2228 x 1652 pixels; pupil-dilated; central posterior field
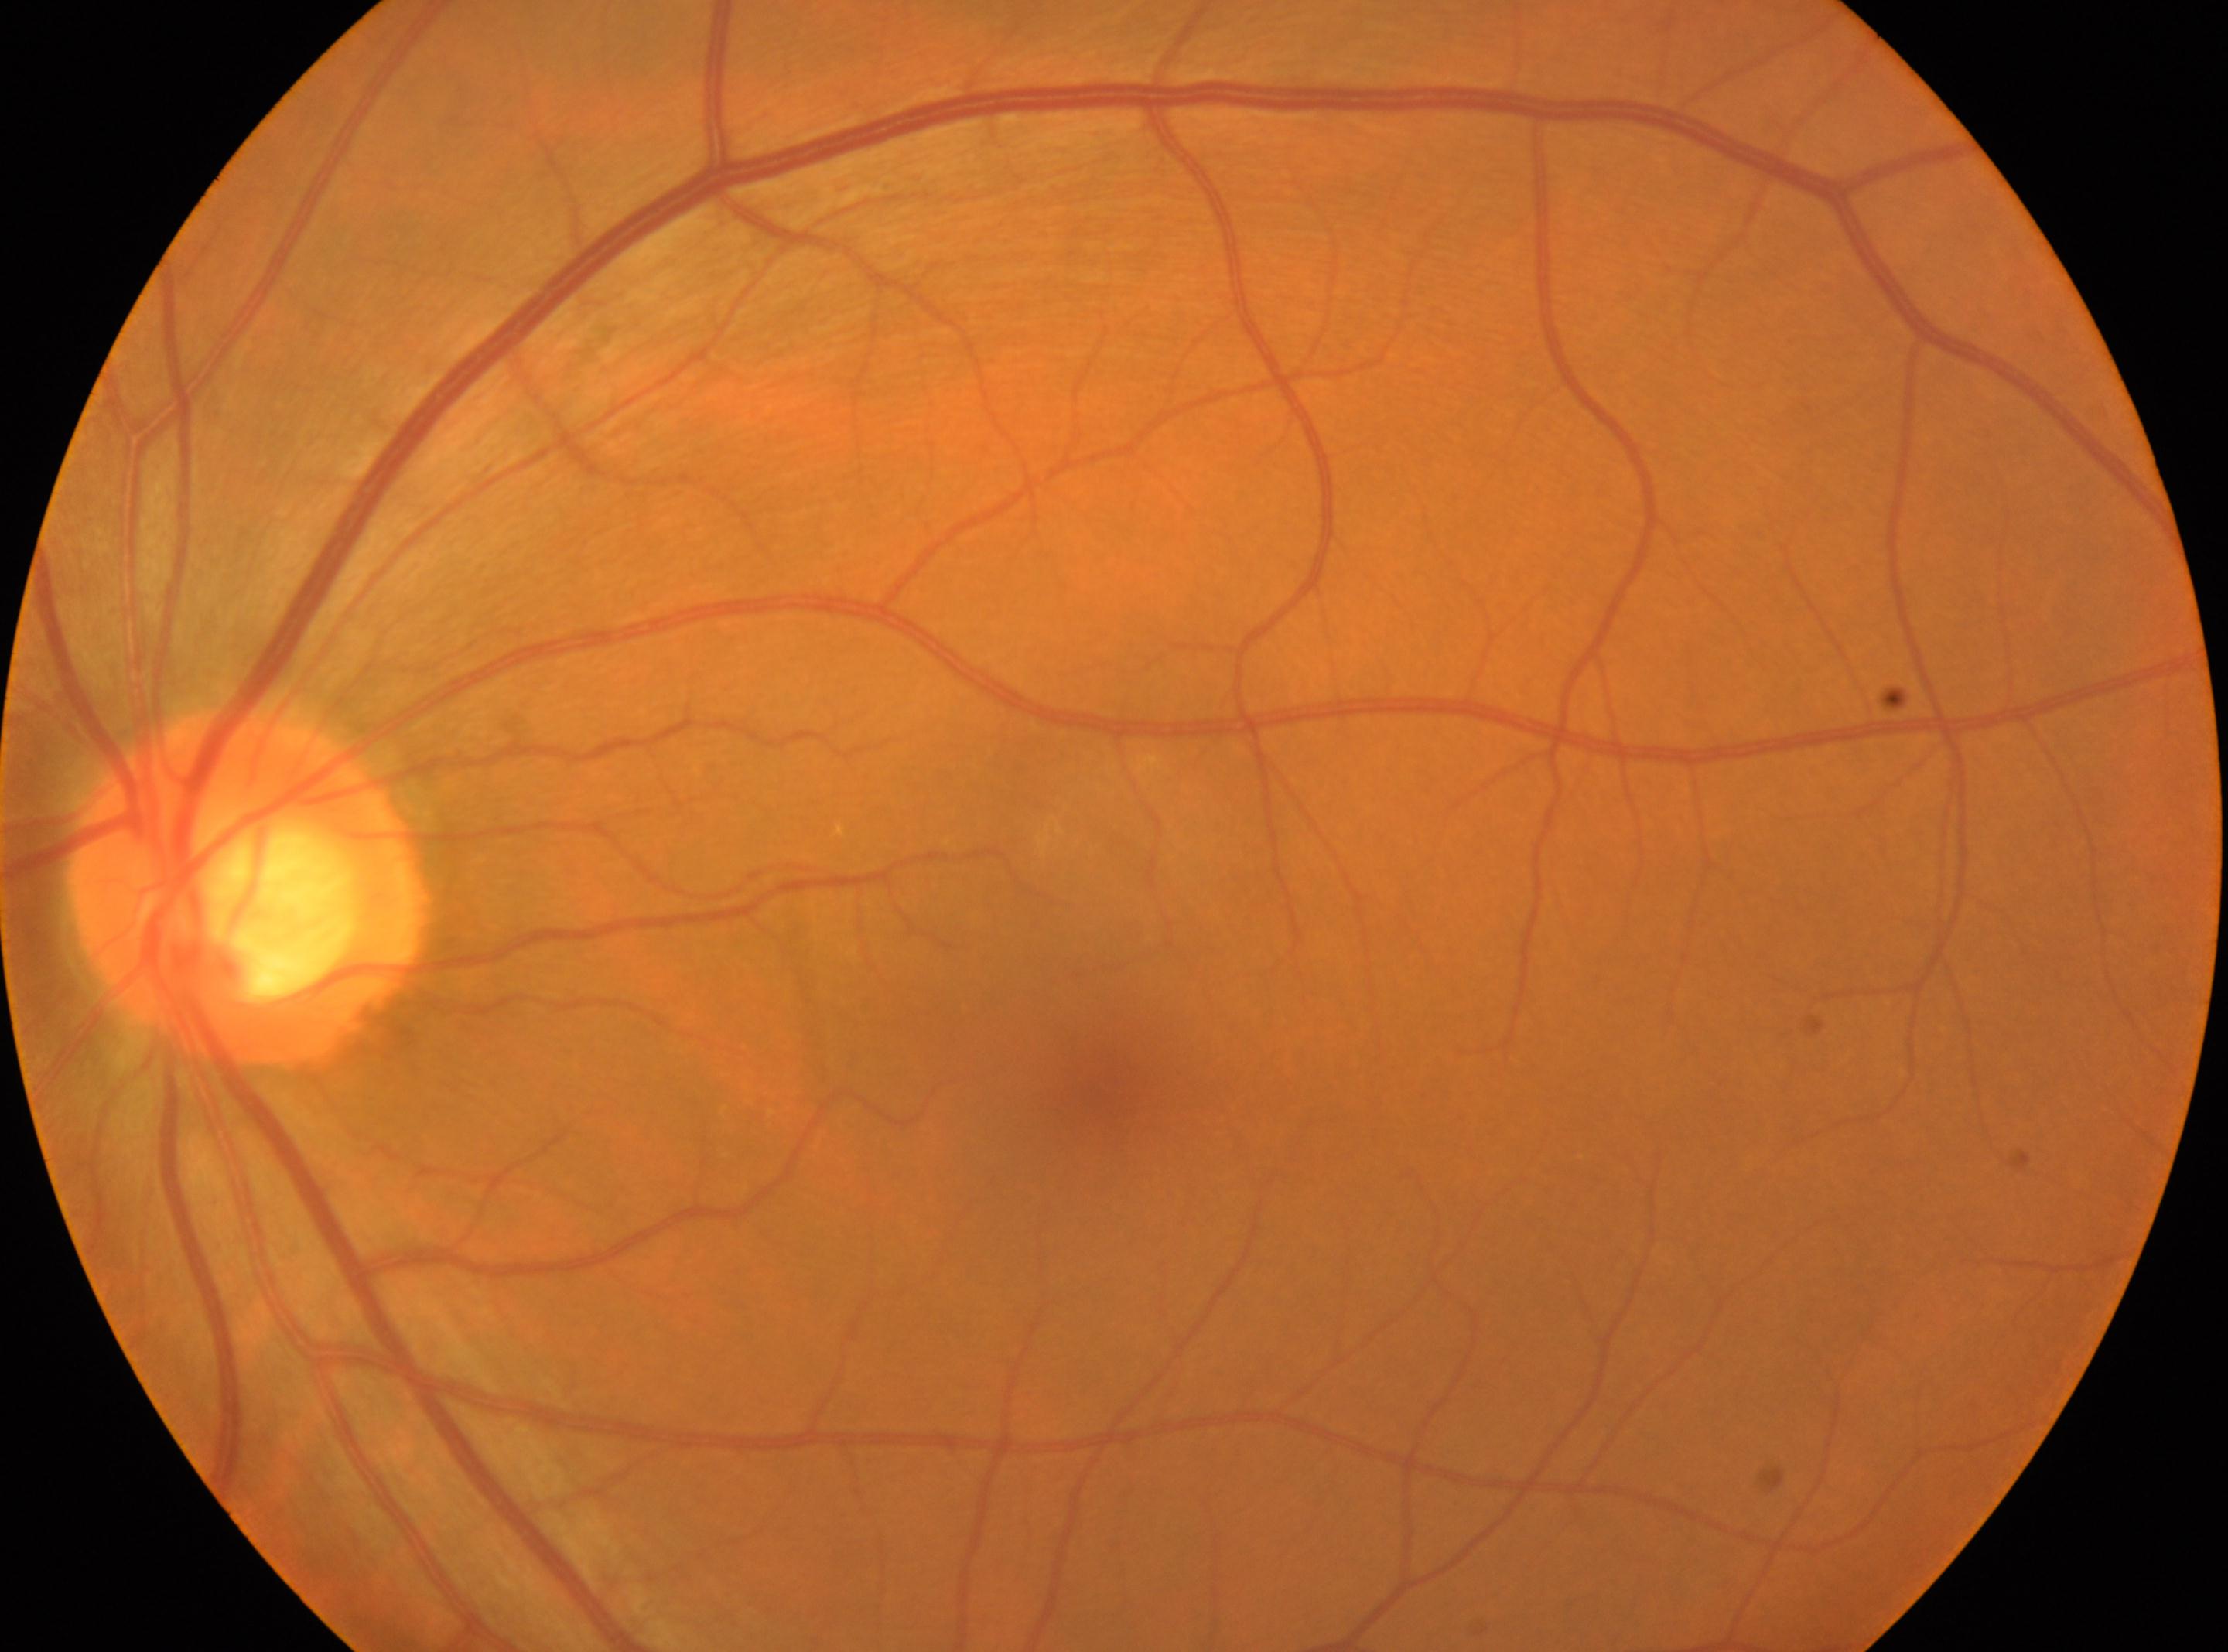 Fovea located at 1099px, 1084px. ONH located at 246px, 889px. Eye: left eye. DR is grade 0 (no apparent retinopathy).